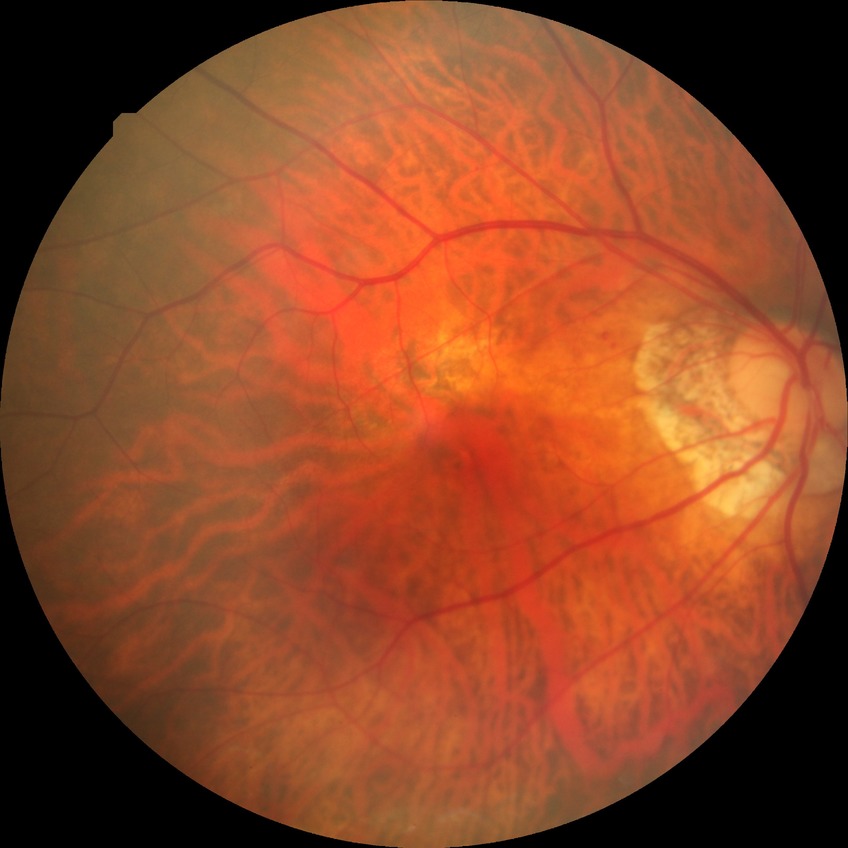
diabetic retinopathy (DR) = simple diabetic retinopathy (SDR).